Camera: NIDEK AFC-230.
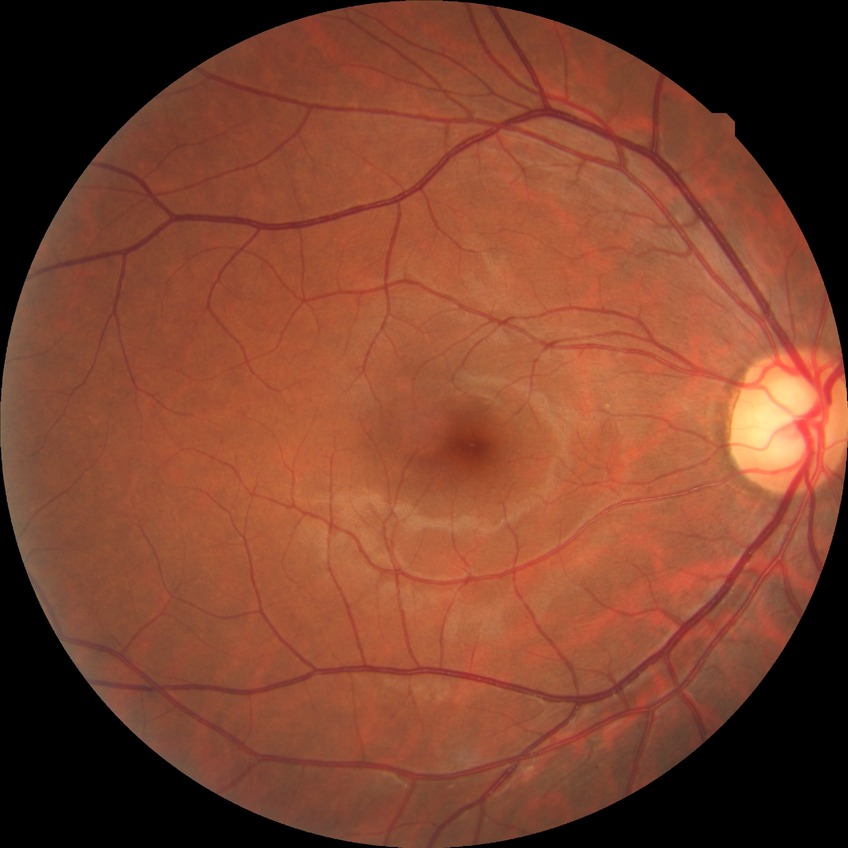 Assessment:
- diabetic retinopathy (DR): NDR (no diabetic retinopathy)